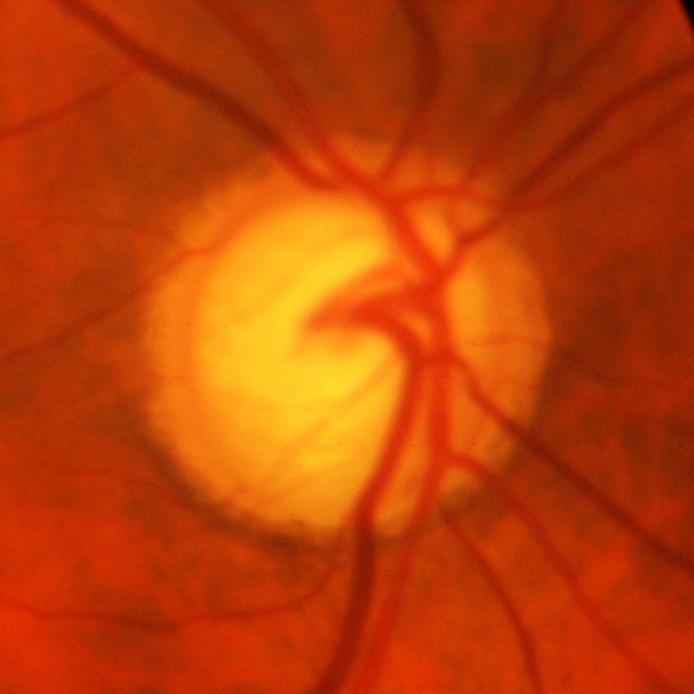
Diagnosis = glaucomatous changes.